848 x 848 pixels. 45° FOV:
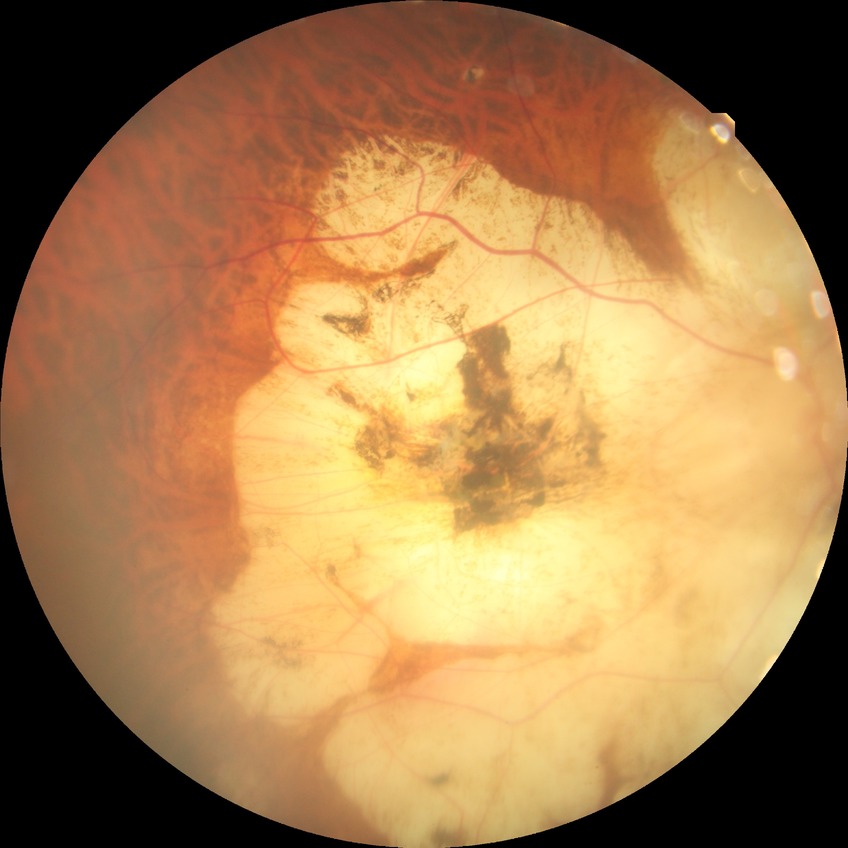

diabetic retinopathy (DR) = no diabetic retinopathy (NDR).